45° FOV:
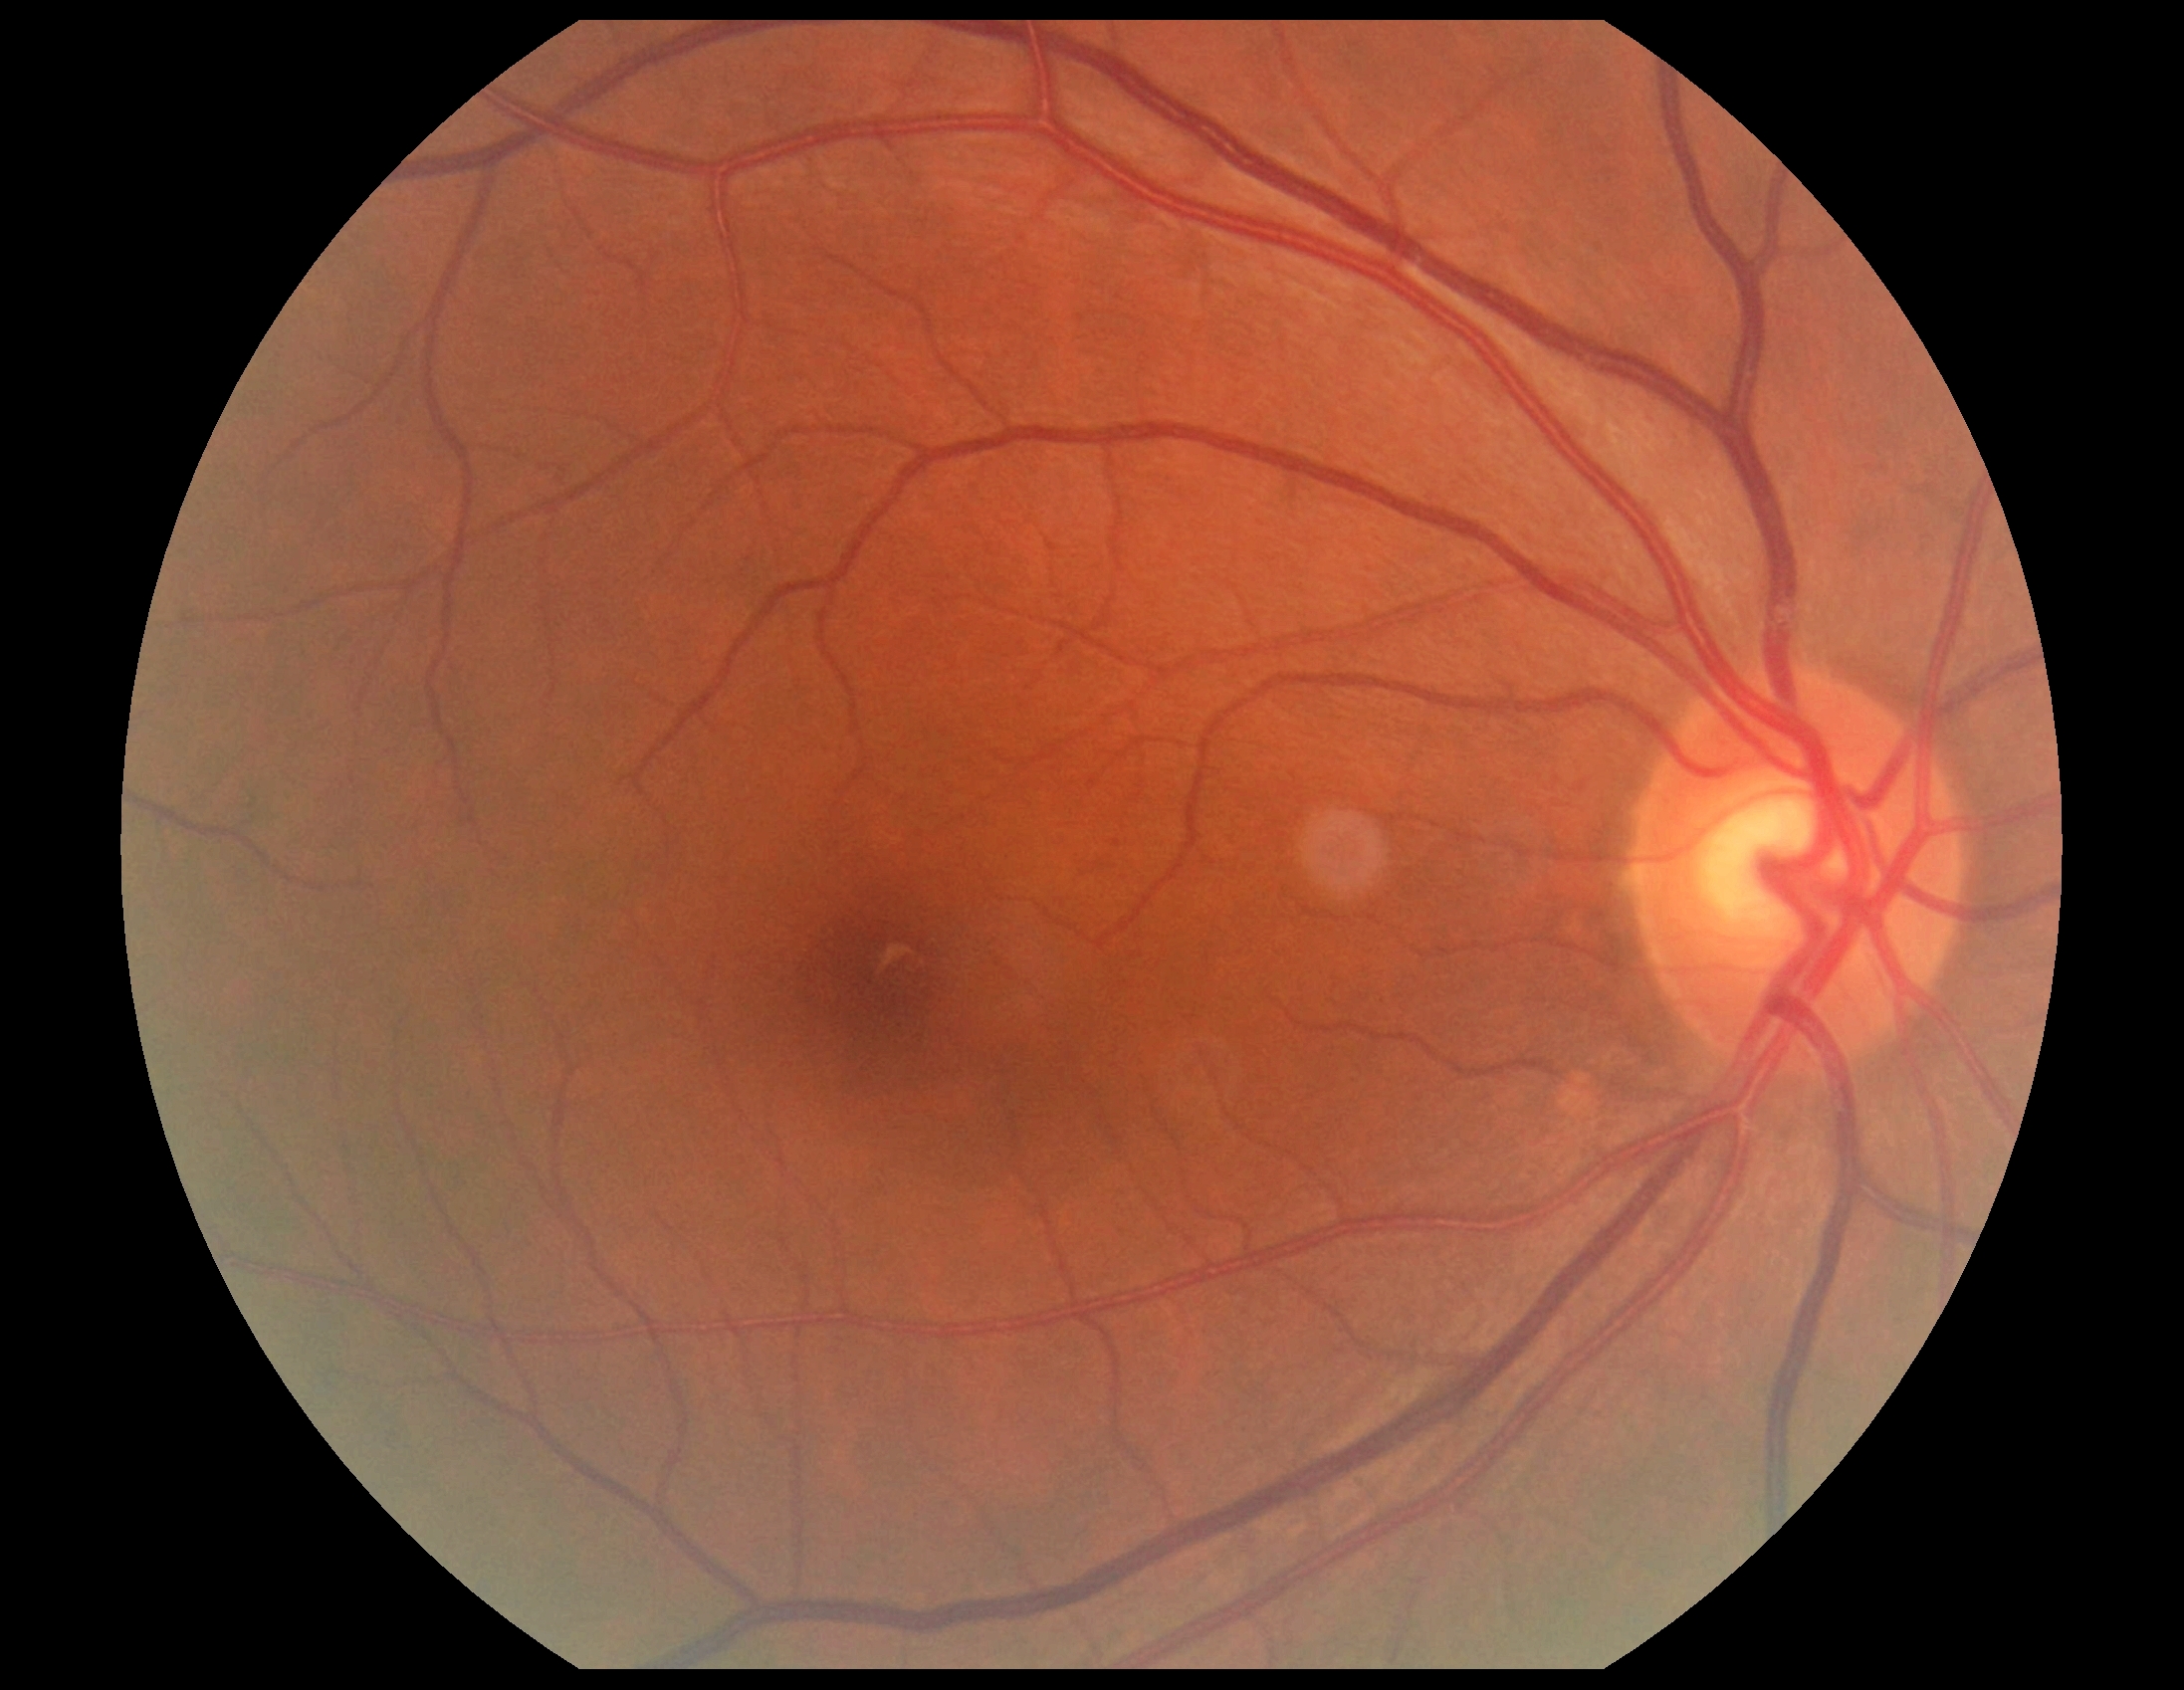

DR impression=no apparent DR; DR grade=no apparent retinopathy (0).